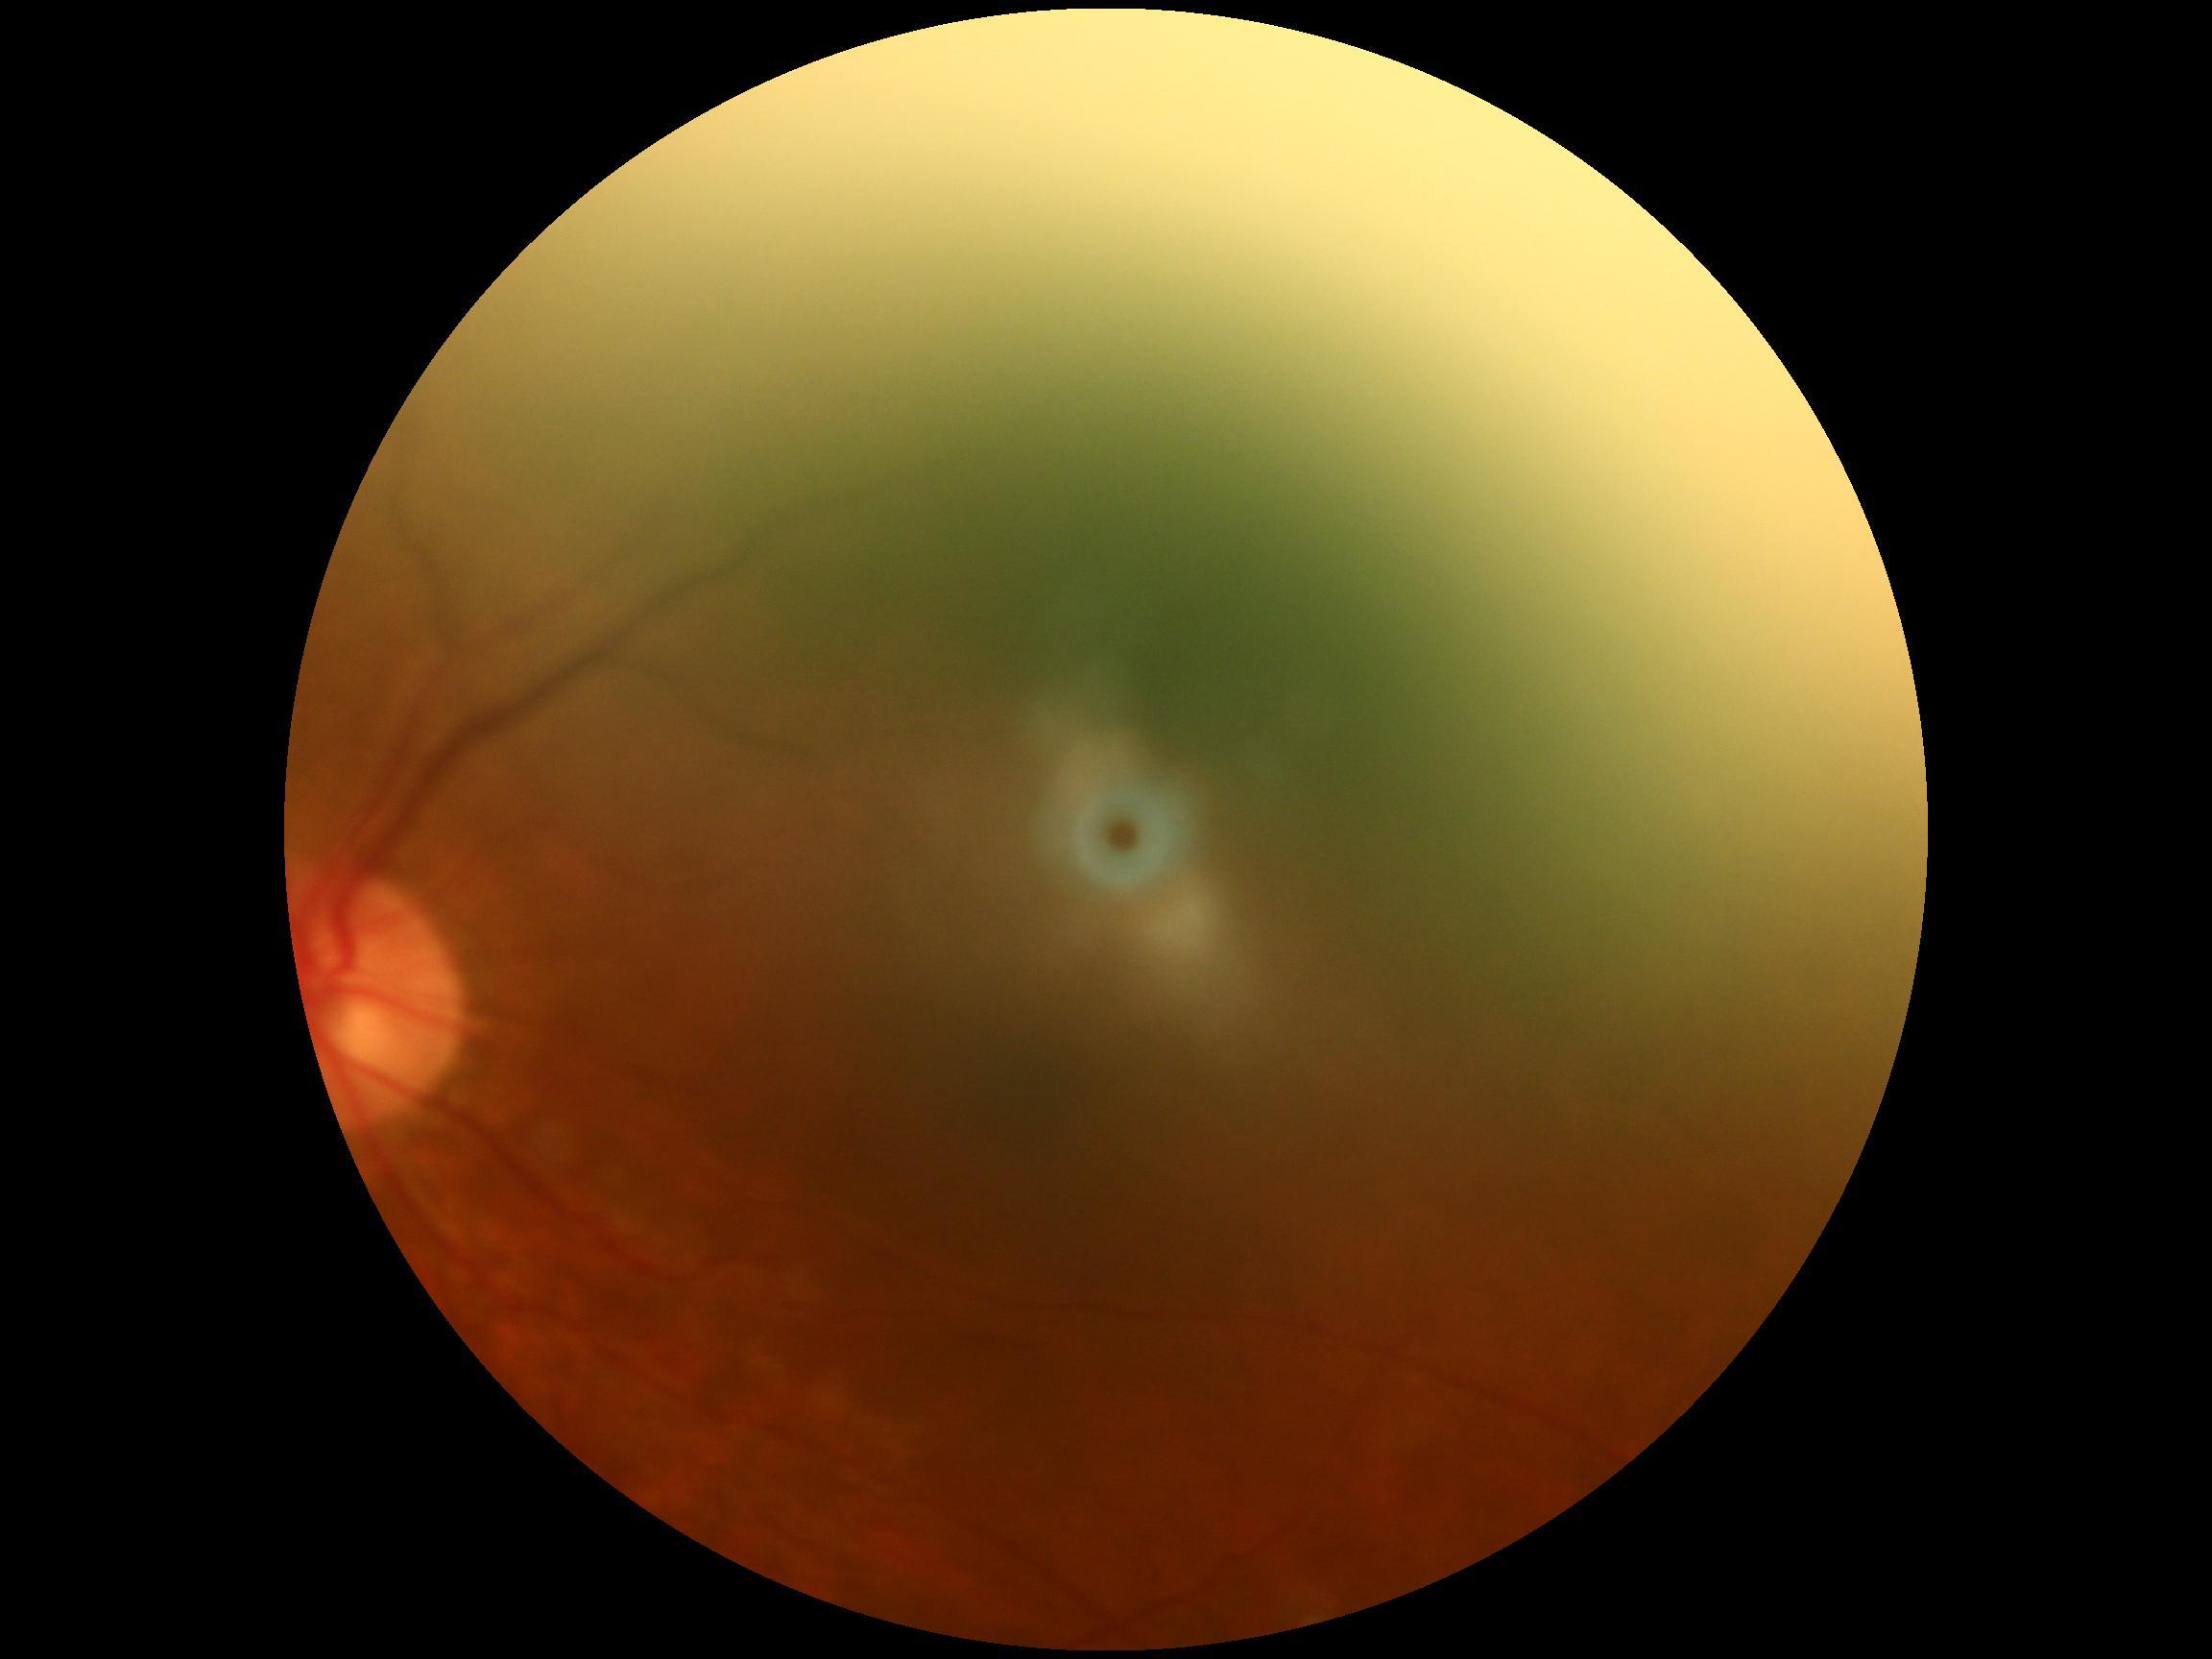
Retinopathy is ungradable.